FOV: 45 degrees, camera: NIDEK AFC-230.
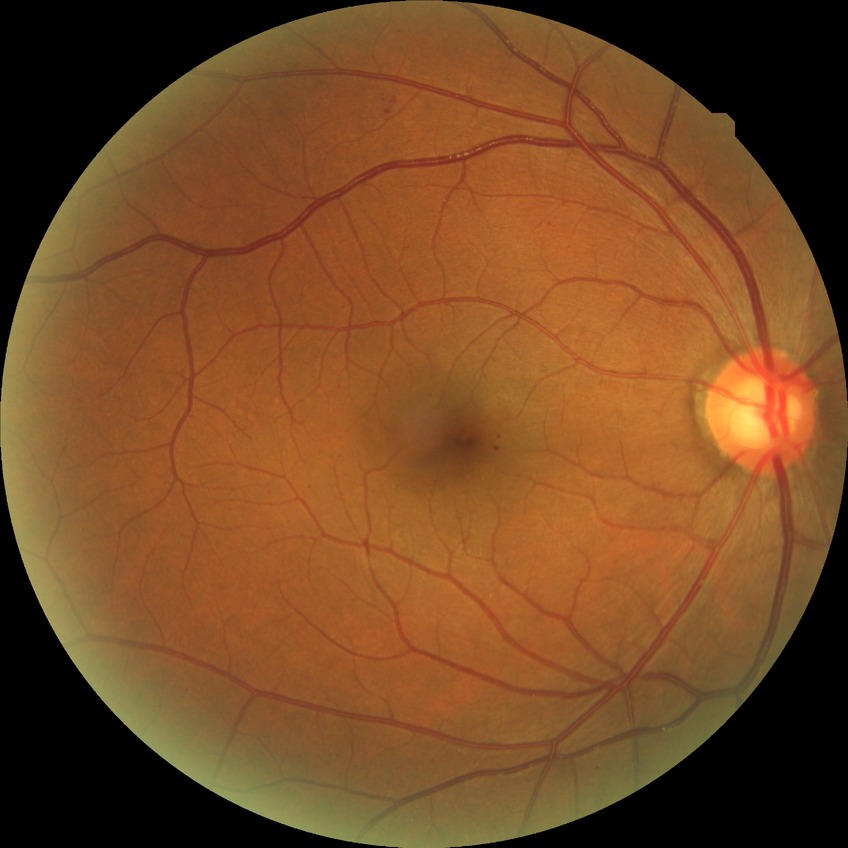
DR grade: SDR.